45° FOV: 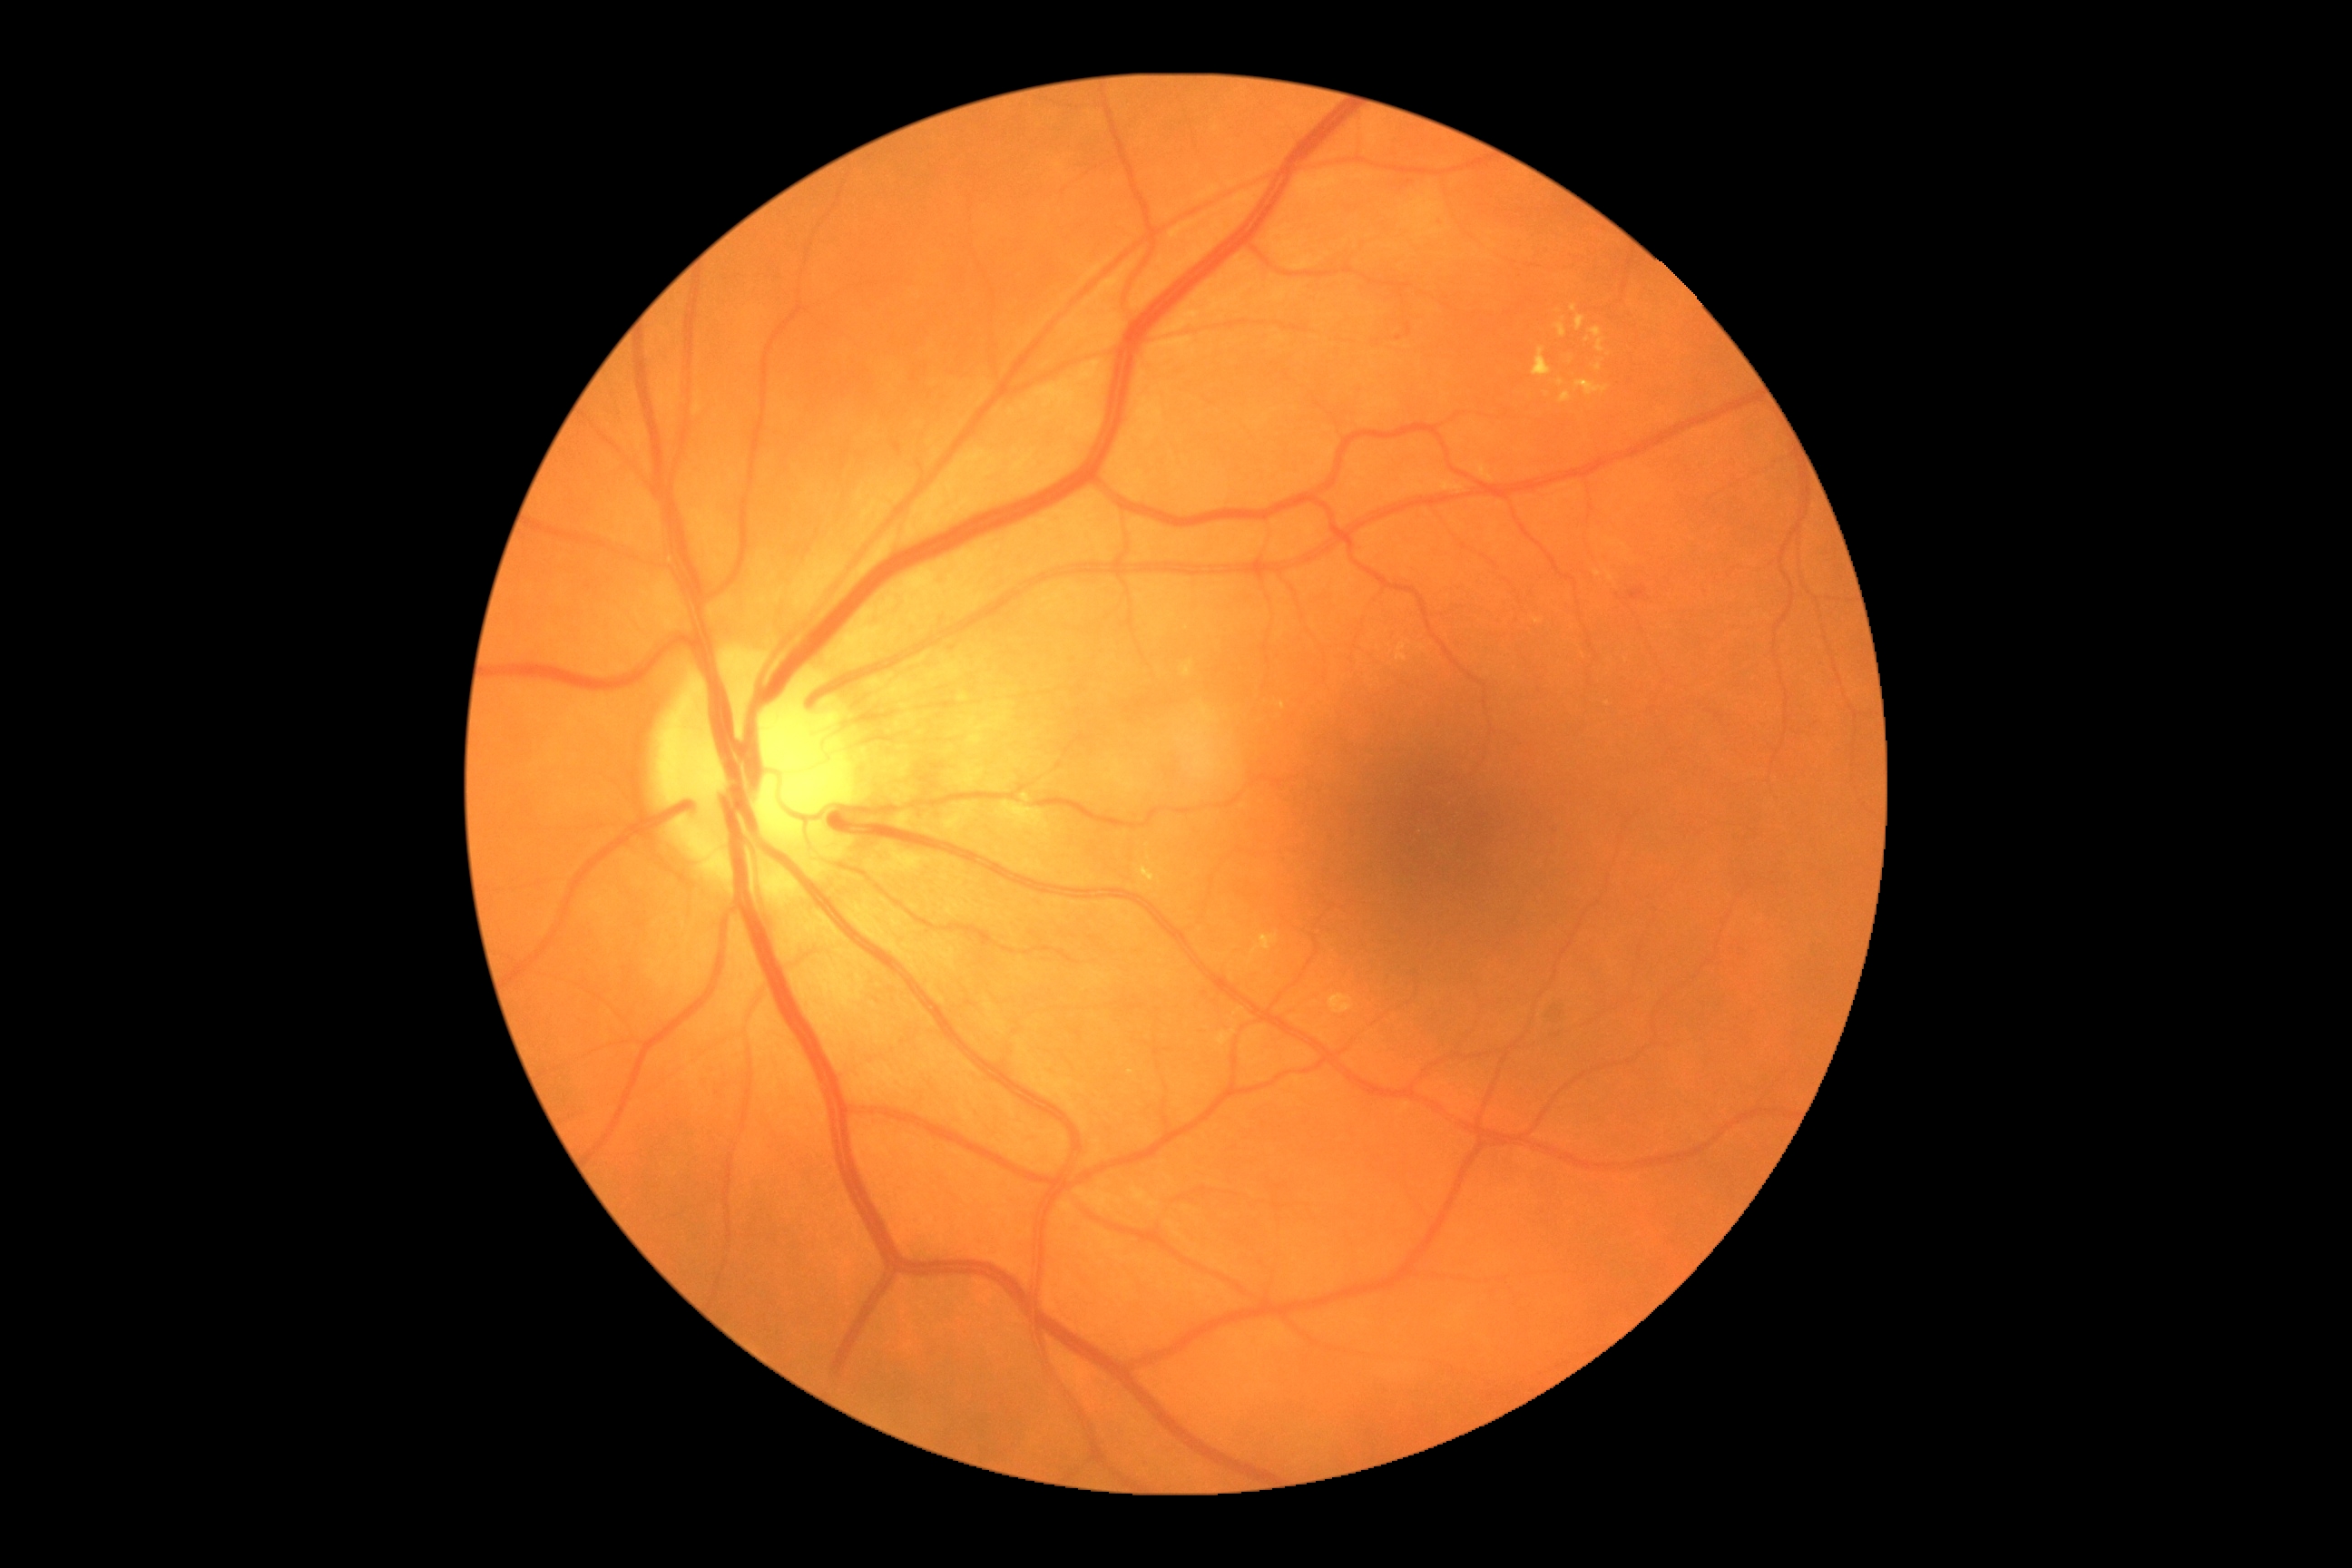 DR class: non-proliferative diabetic retinopathy
DR stage: 2/4